FOV: 45 degrees
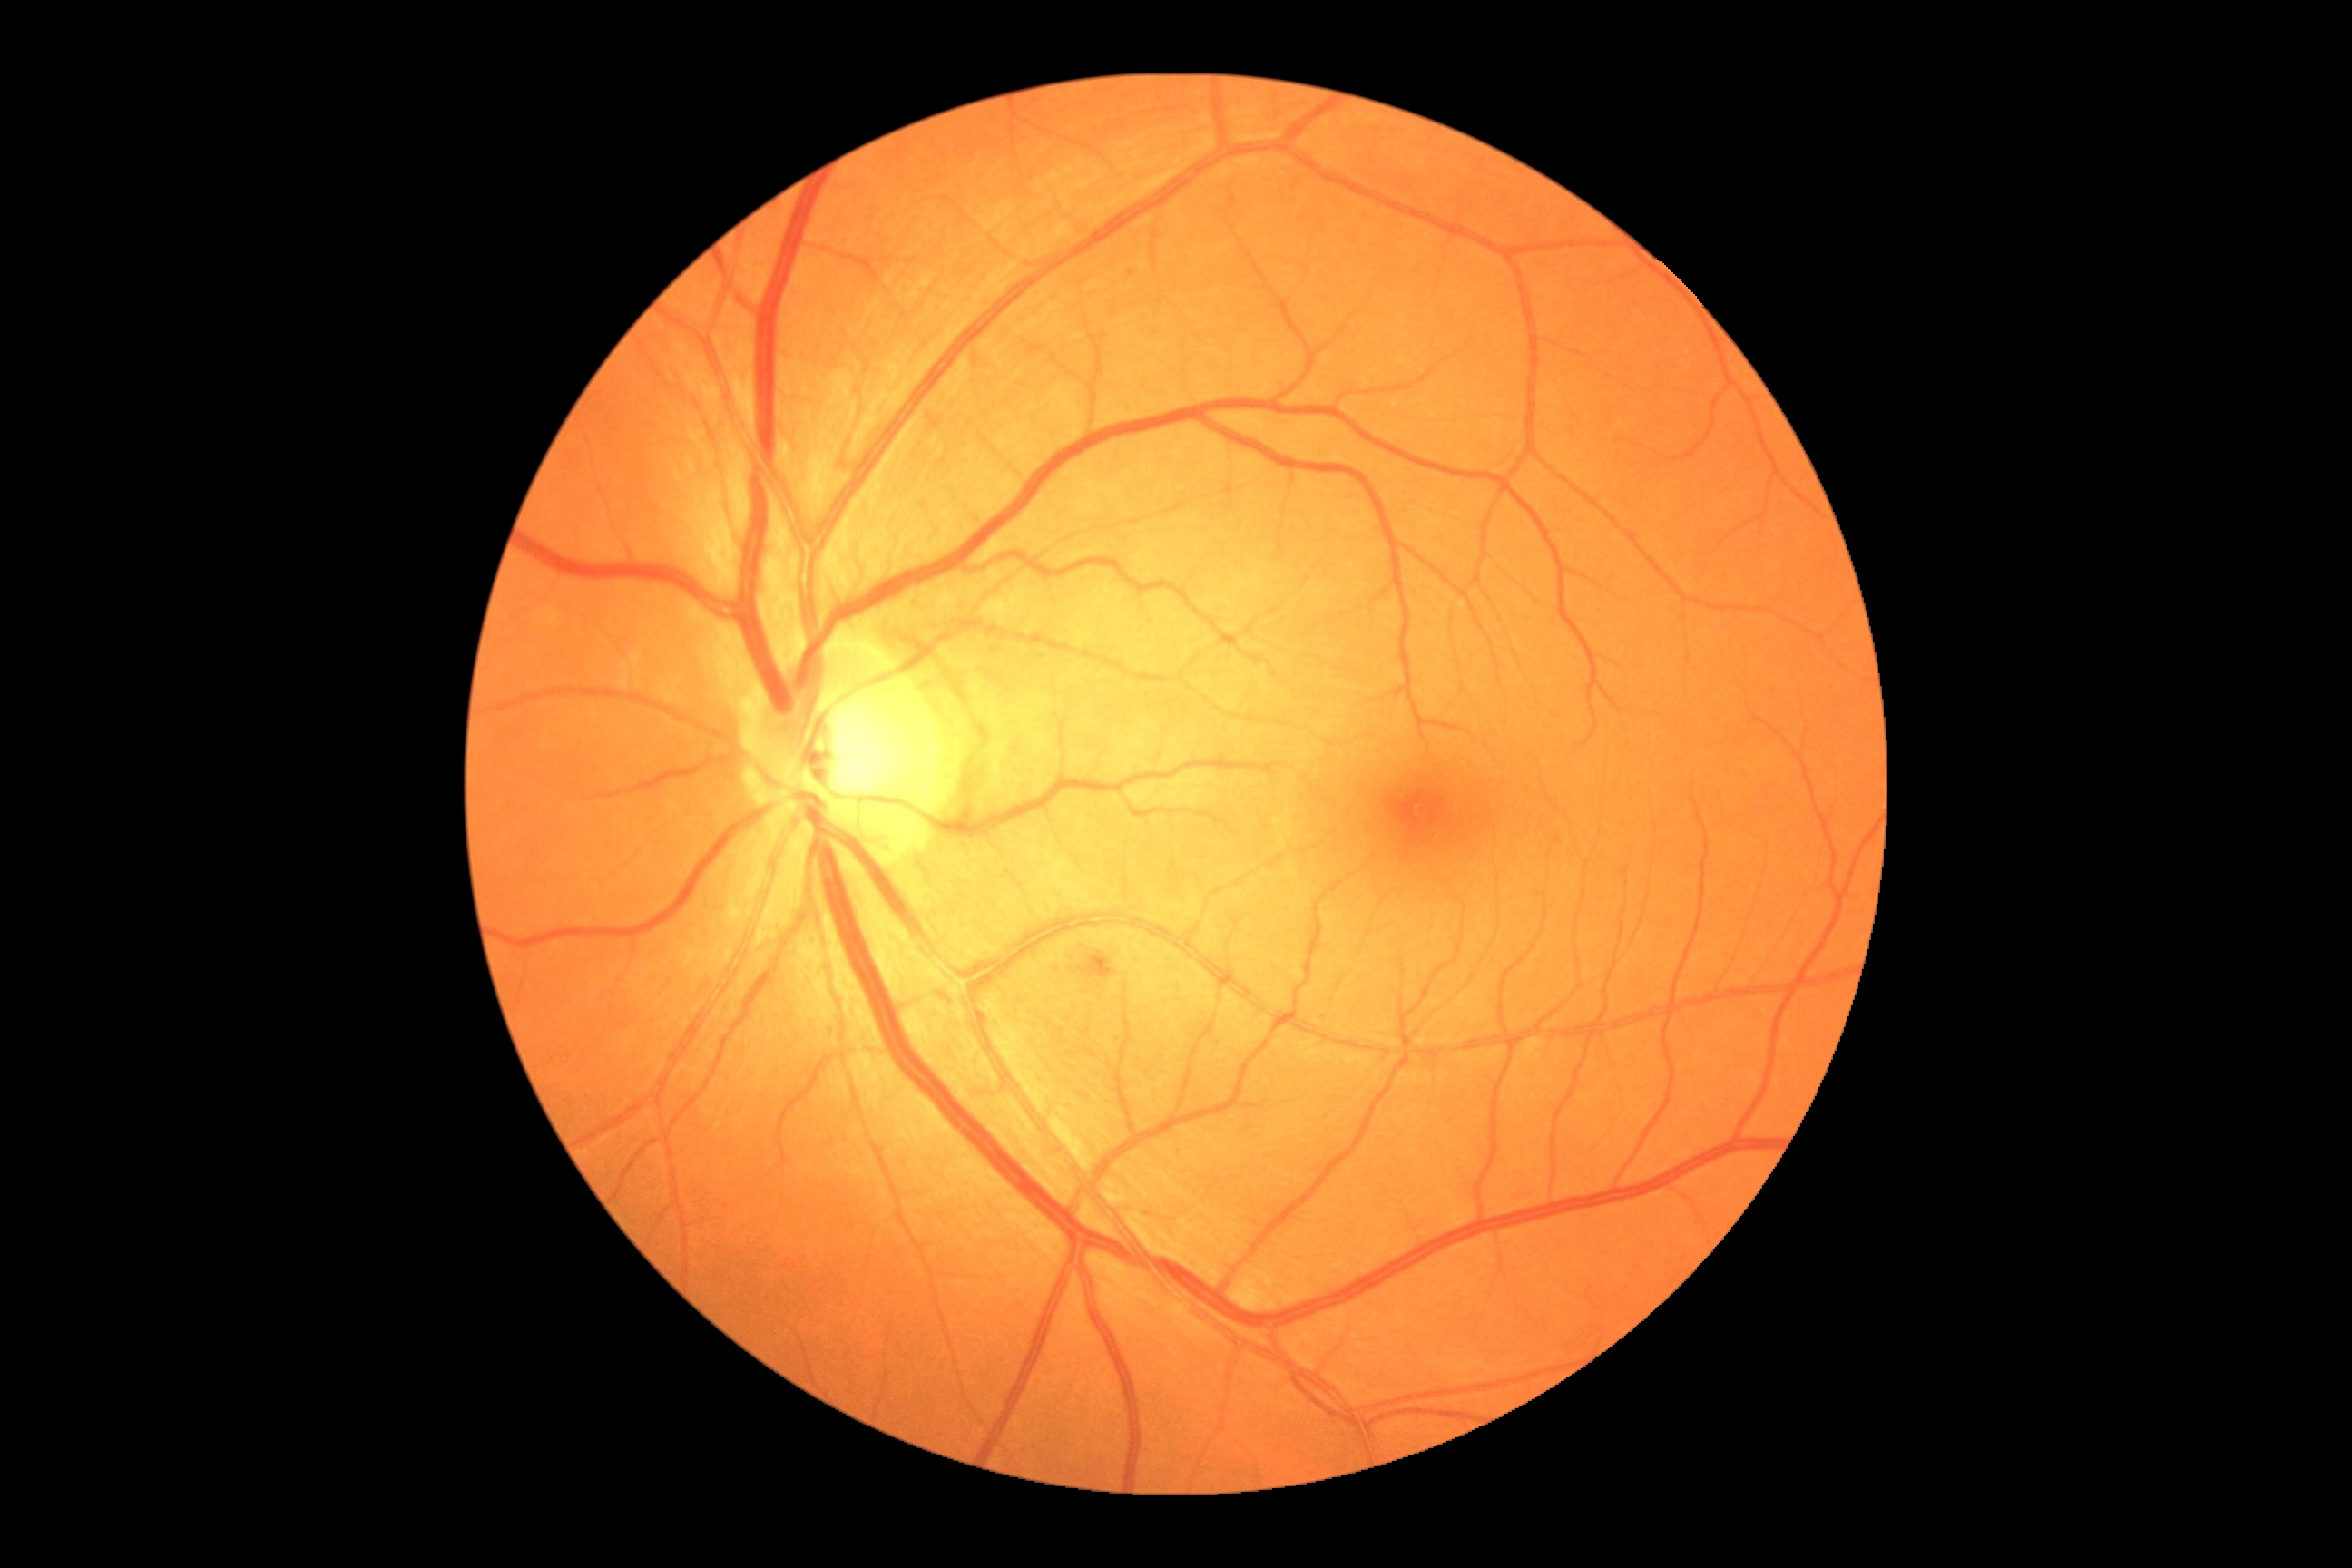
Diabetic retinopathy severity: 2.